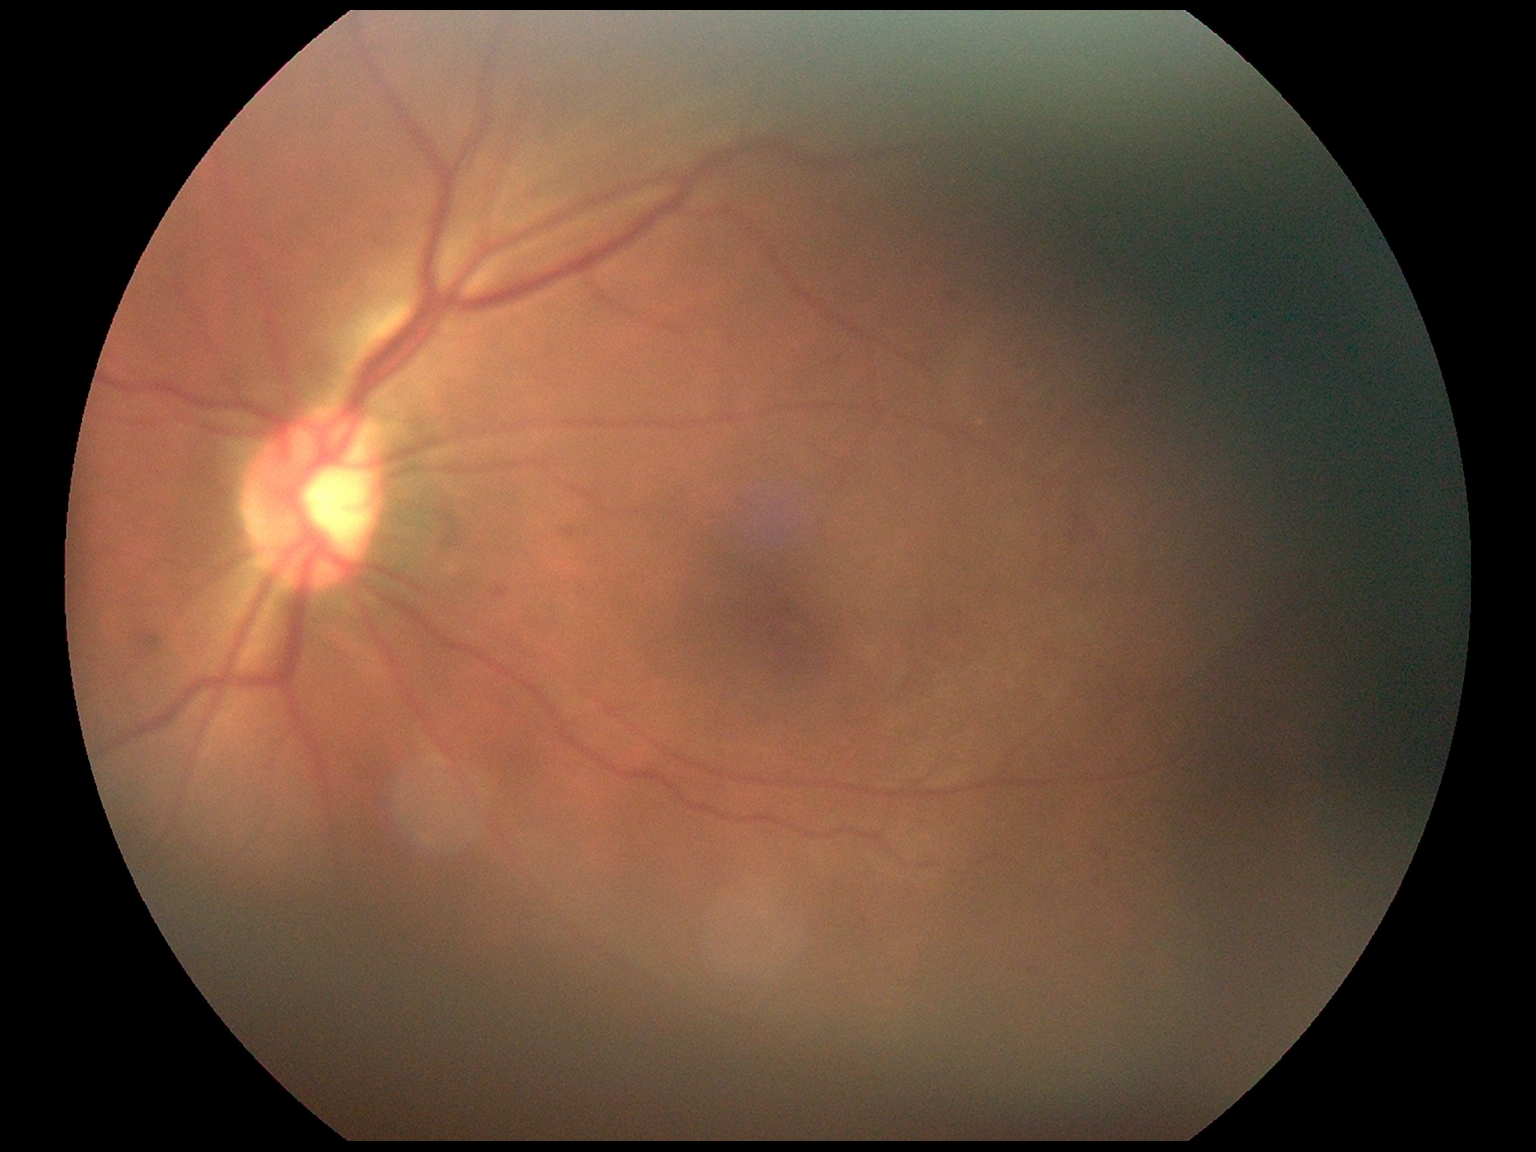
Diabetic retinopathy (DR) is moderate non-proliferative diabetic retinopathy (grade 2).